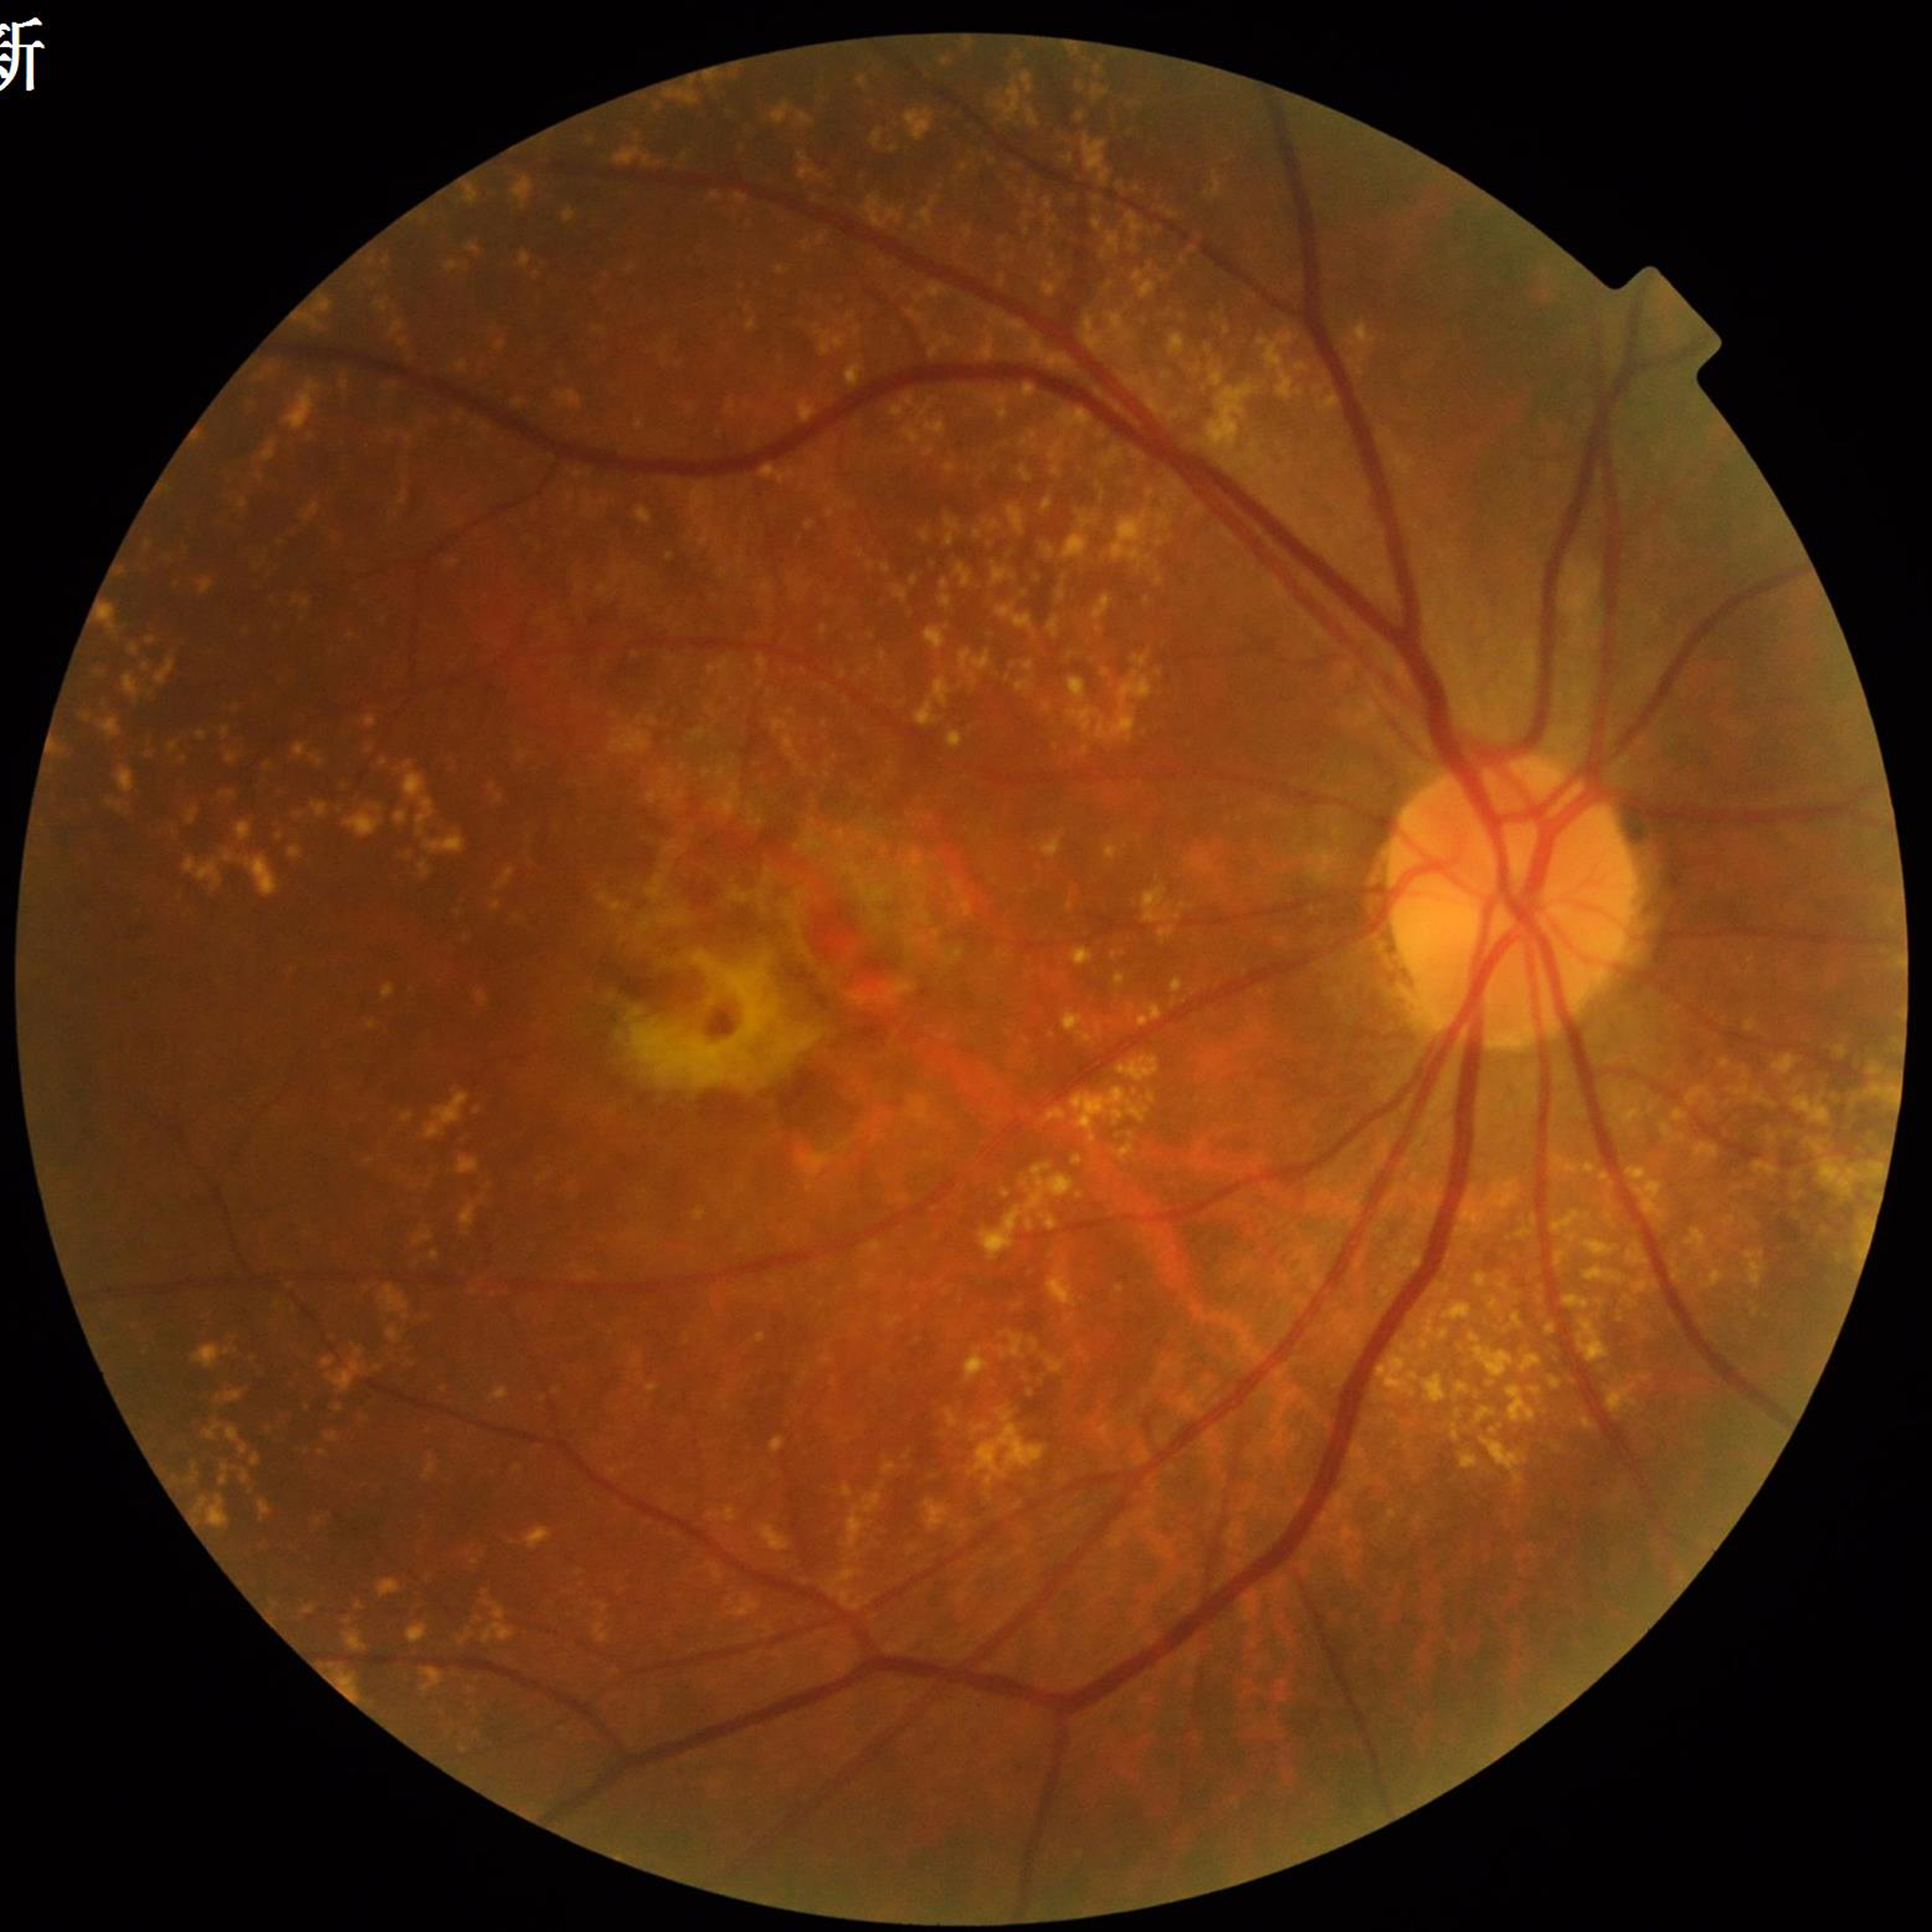 Fundus image of an eye with age-related macular degeneration.